Acquired on the Clarity RetCam 3; wide-field fundus photograph of an infant:
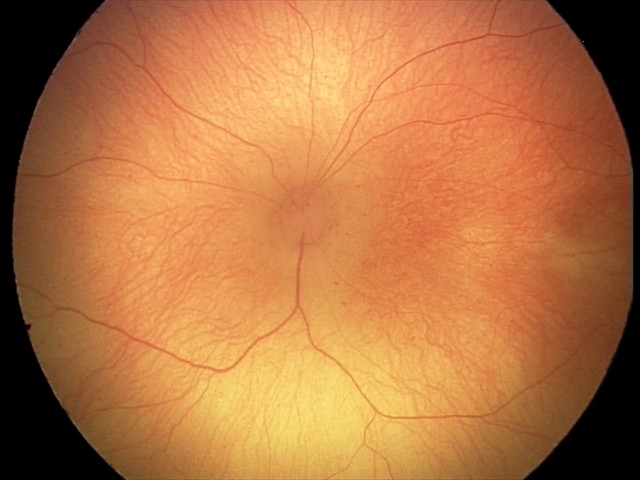

Plus form = absent; impression = retinopathy of prematurity (ROP) stage 1 — demarcation line between vascular and avascular retina.